Optic disc-centered crop, Nidek AFC-330:
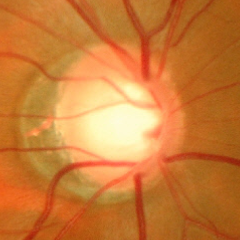

Glaucoma stage: severe glaucomatous damage.